848 by 848 pixels — 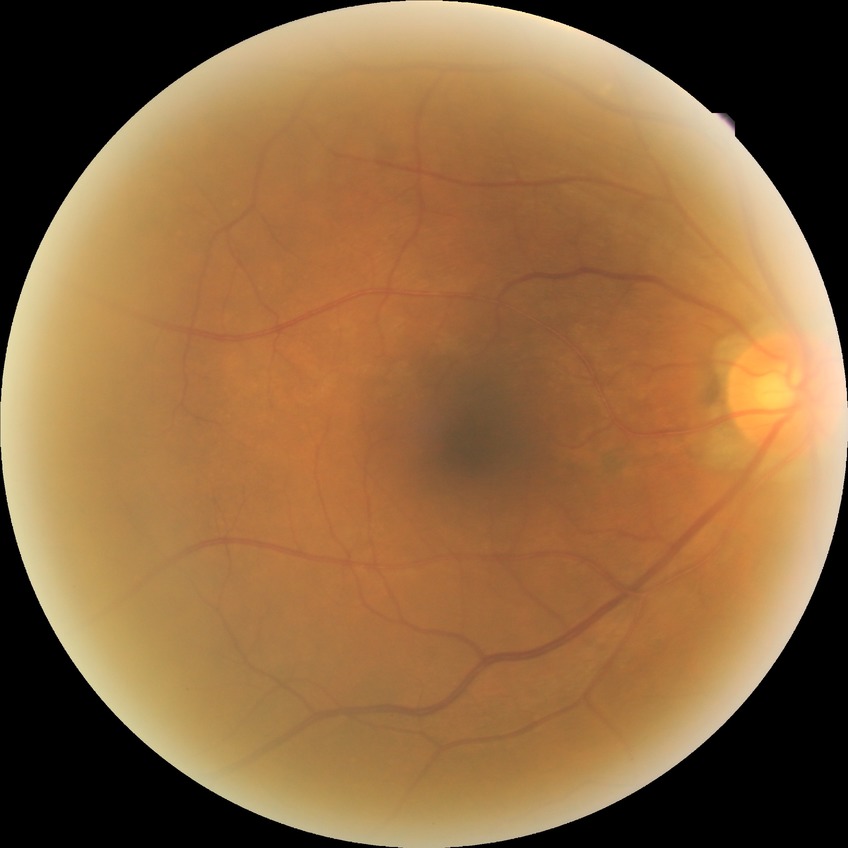 davis_grade: NDR (no diabetic retinopathy)